Fundus photo; 2352x1568px; 45-degree field of view
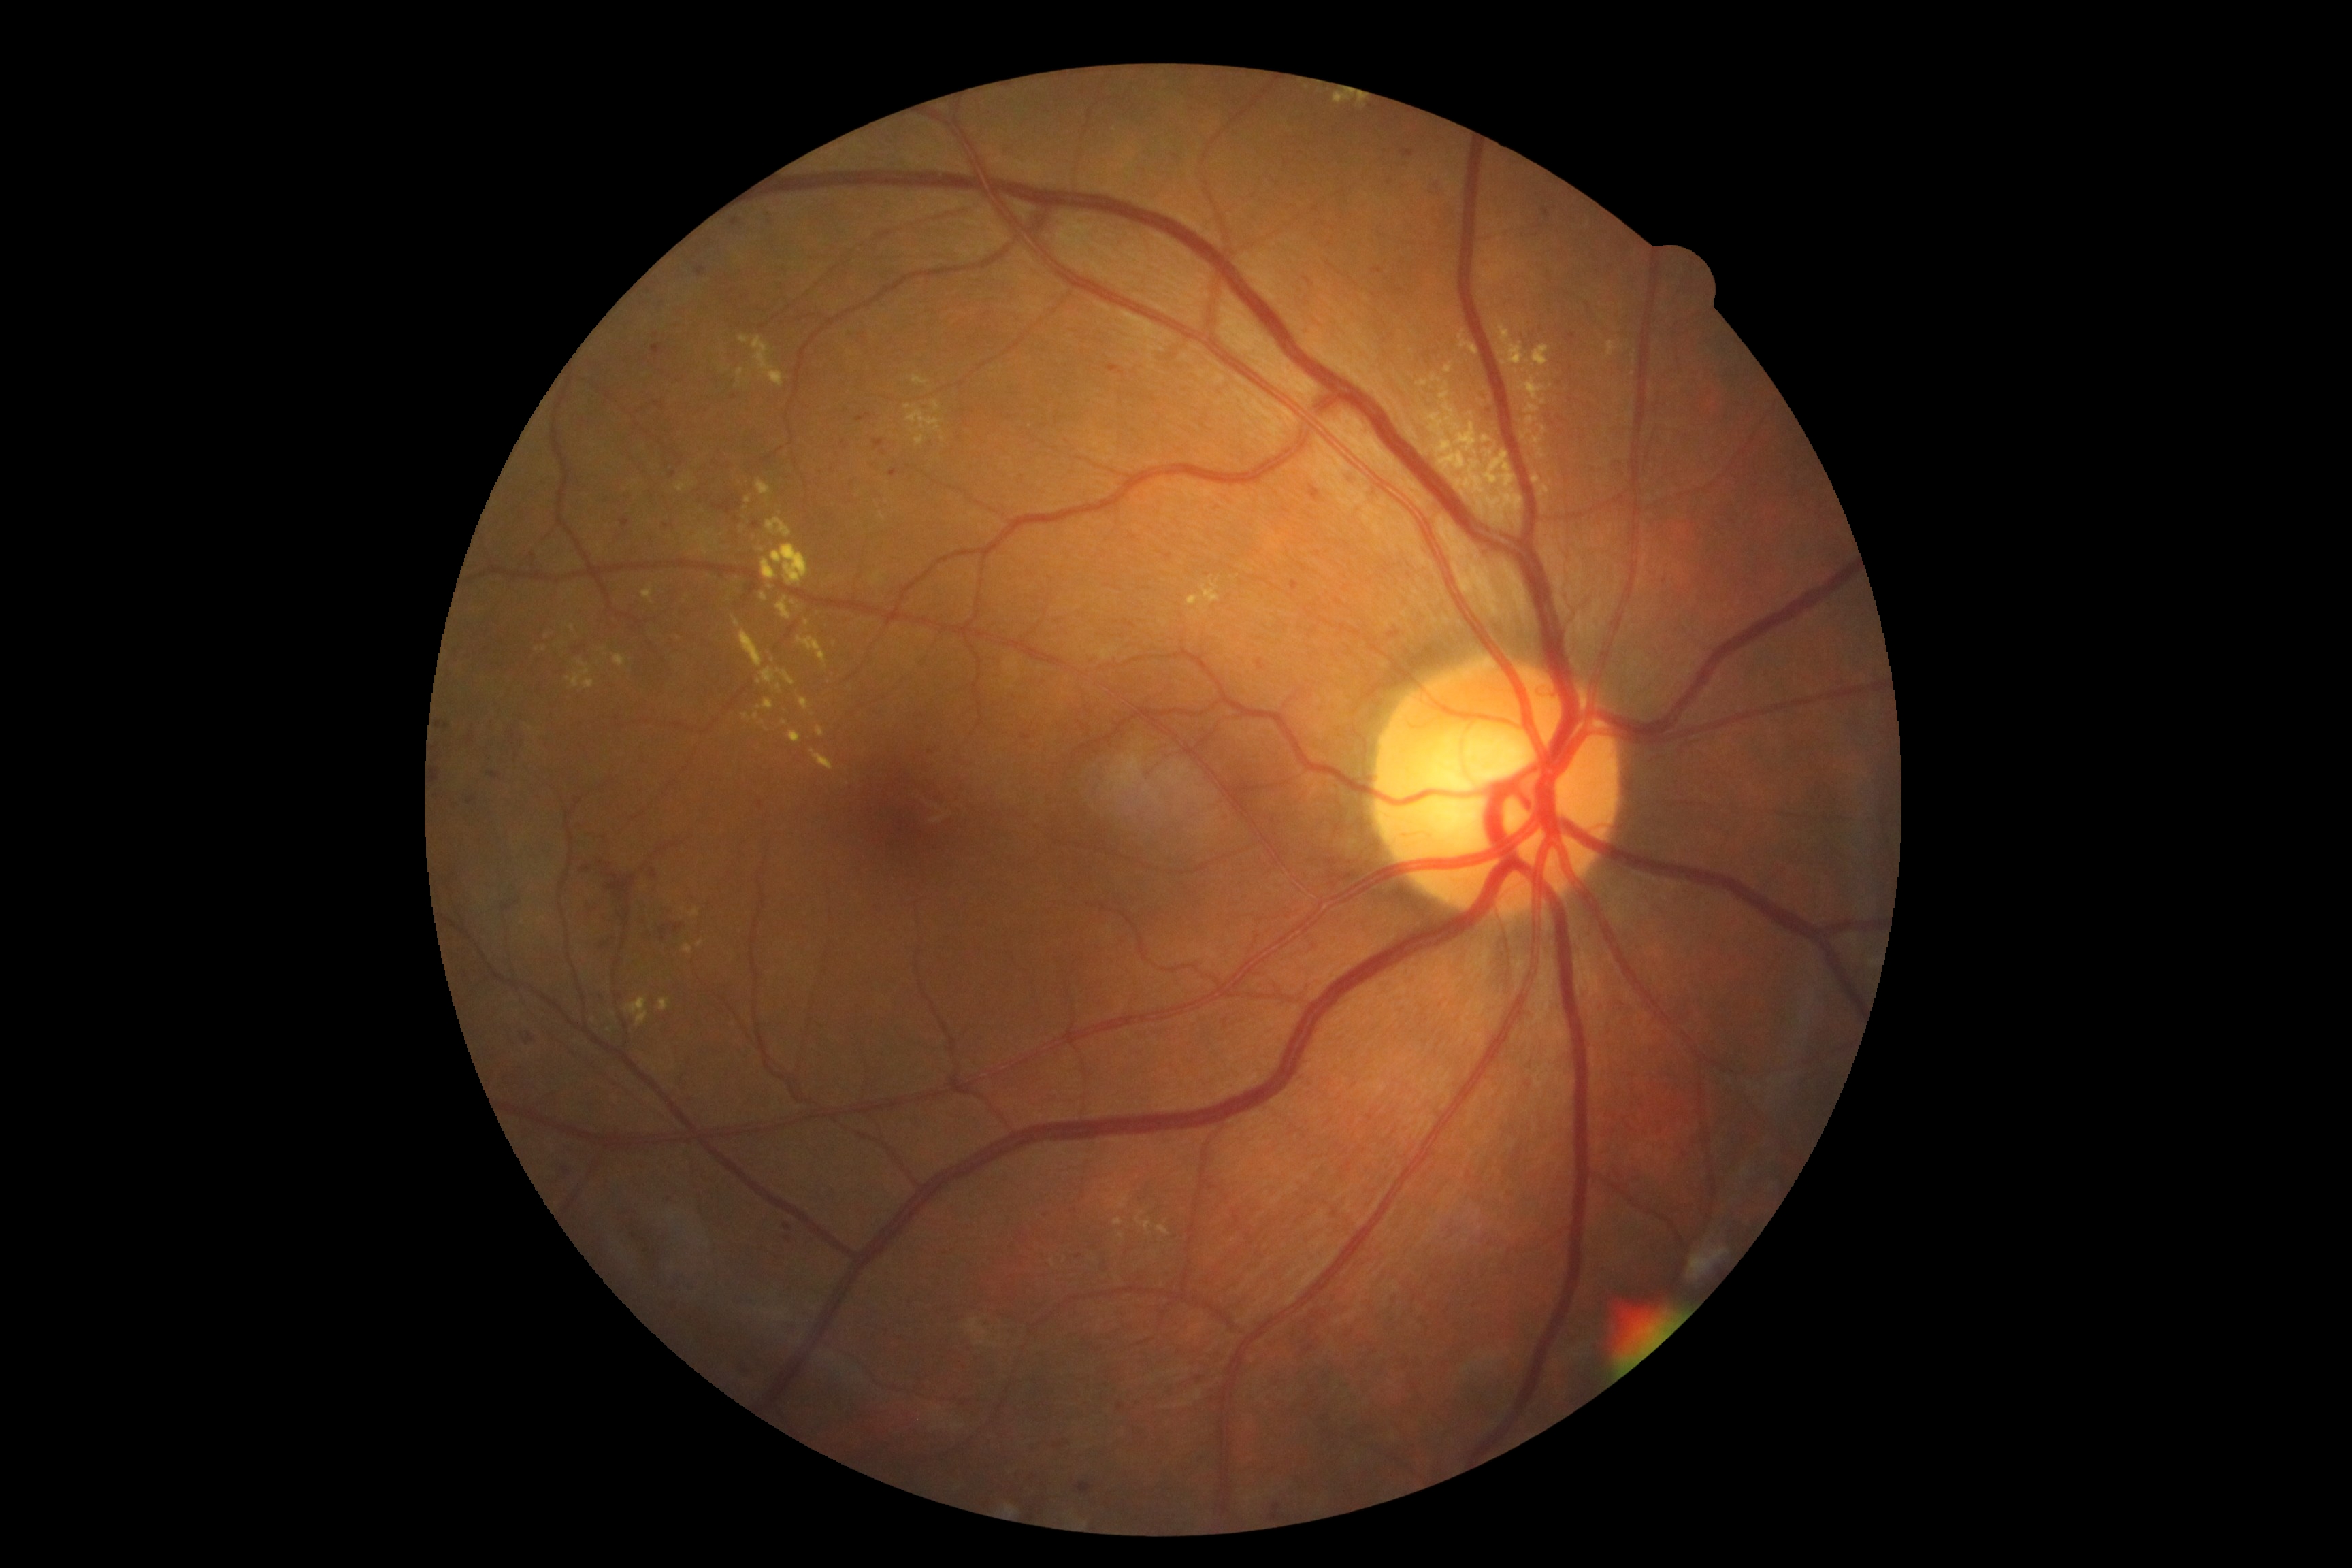

Diabetic retinopathy grade: 2 — more than just microaneurysms but less than severe NPDR.